Infant wide-field retinal image. Camera: Natus RetCam Envision (130° FOV):
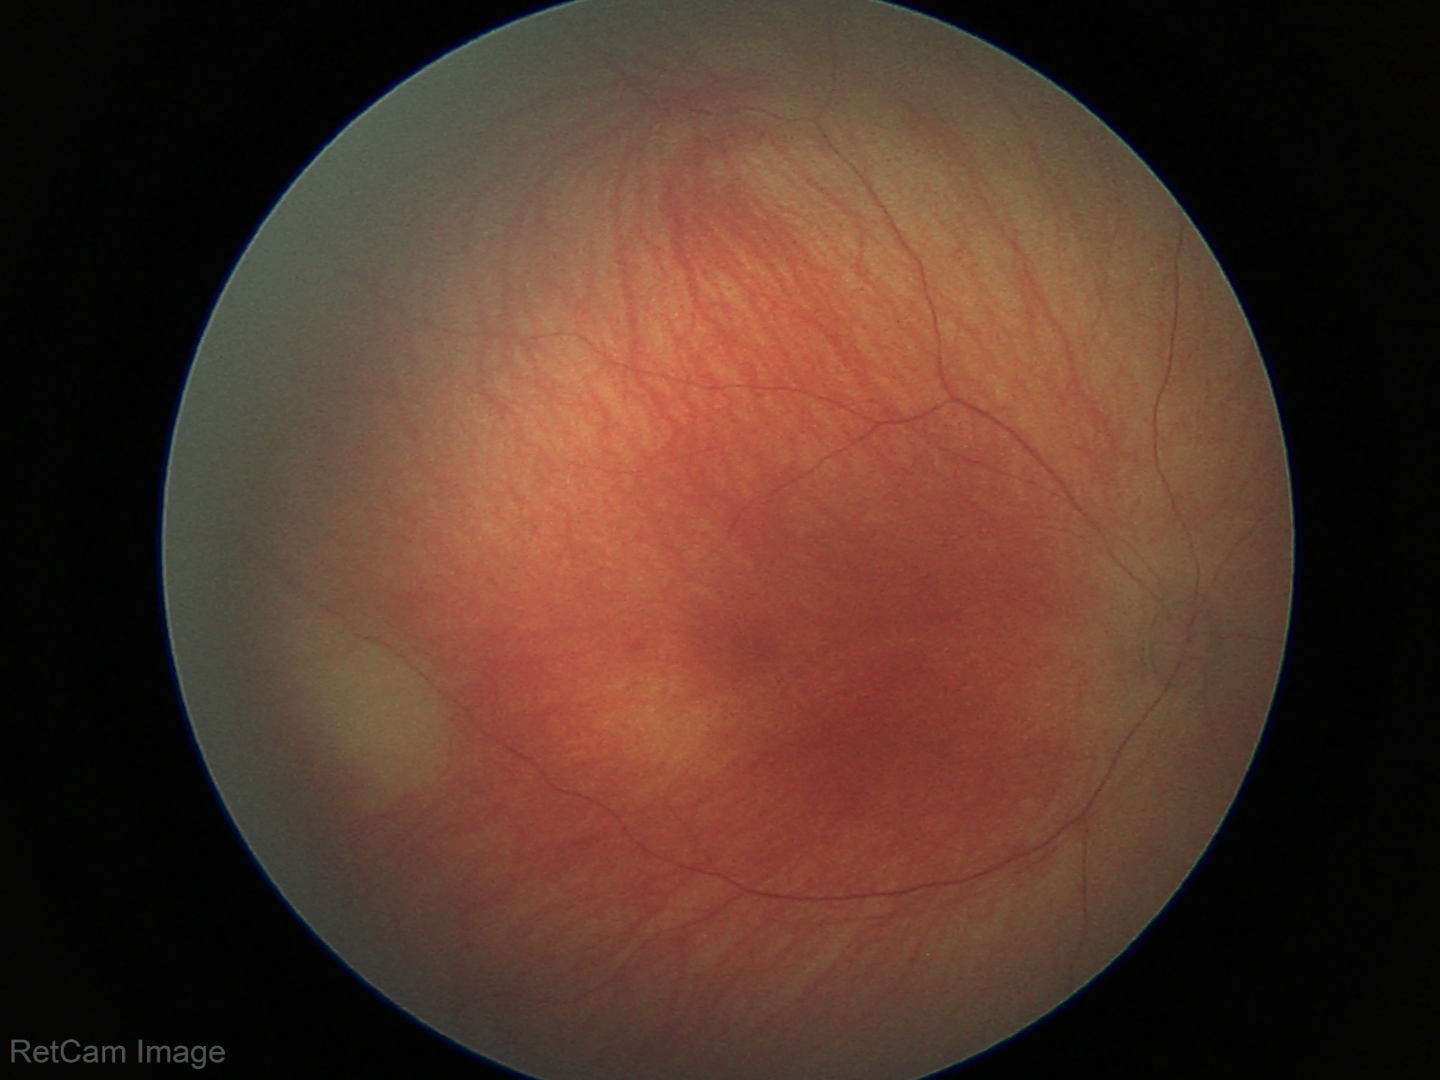 Examination with physiological retinal findings.